Color fundus photograph. 2184 x 1690 pixels. 45° field of view.
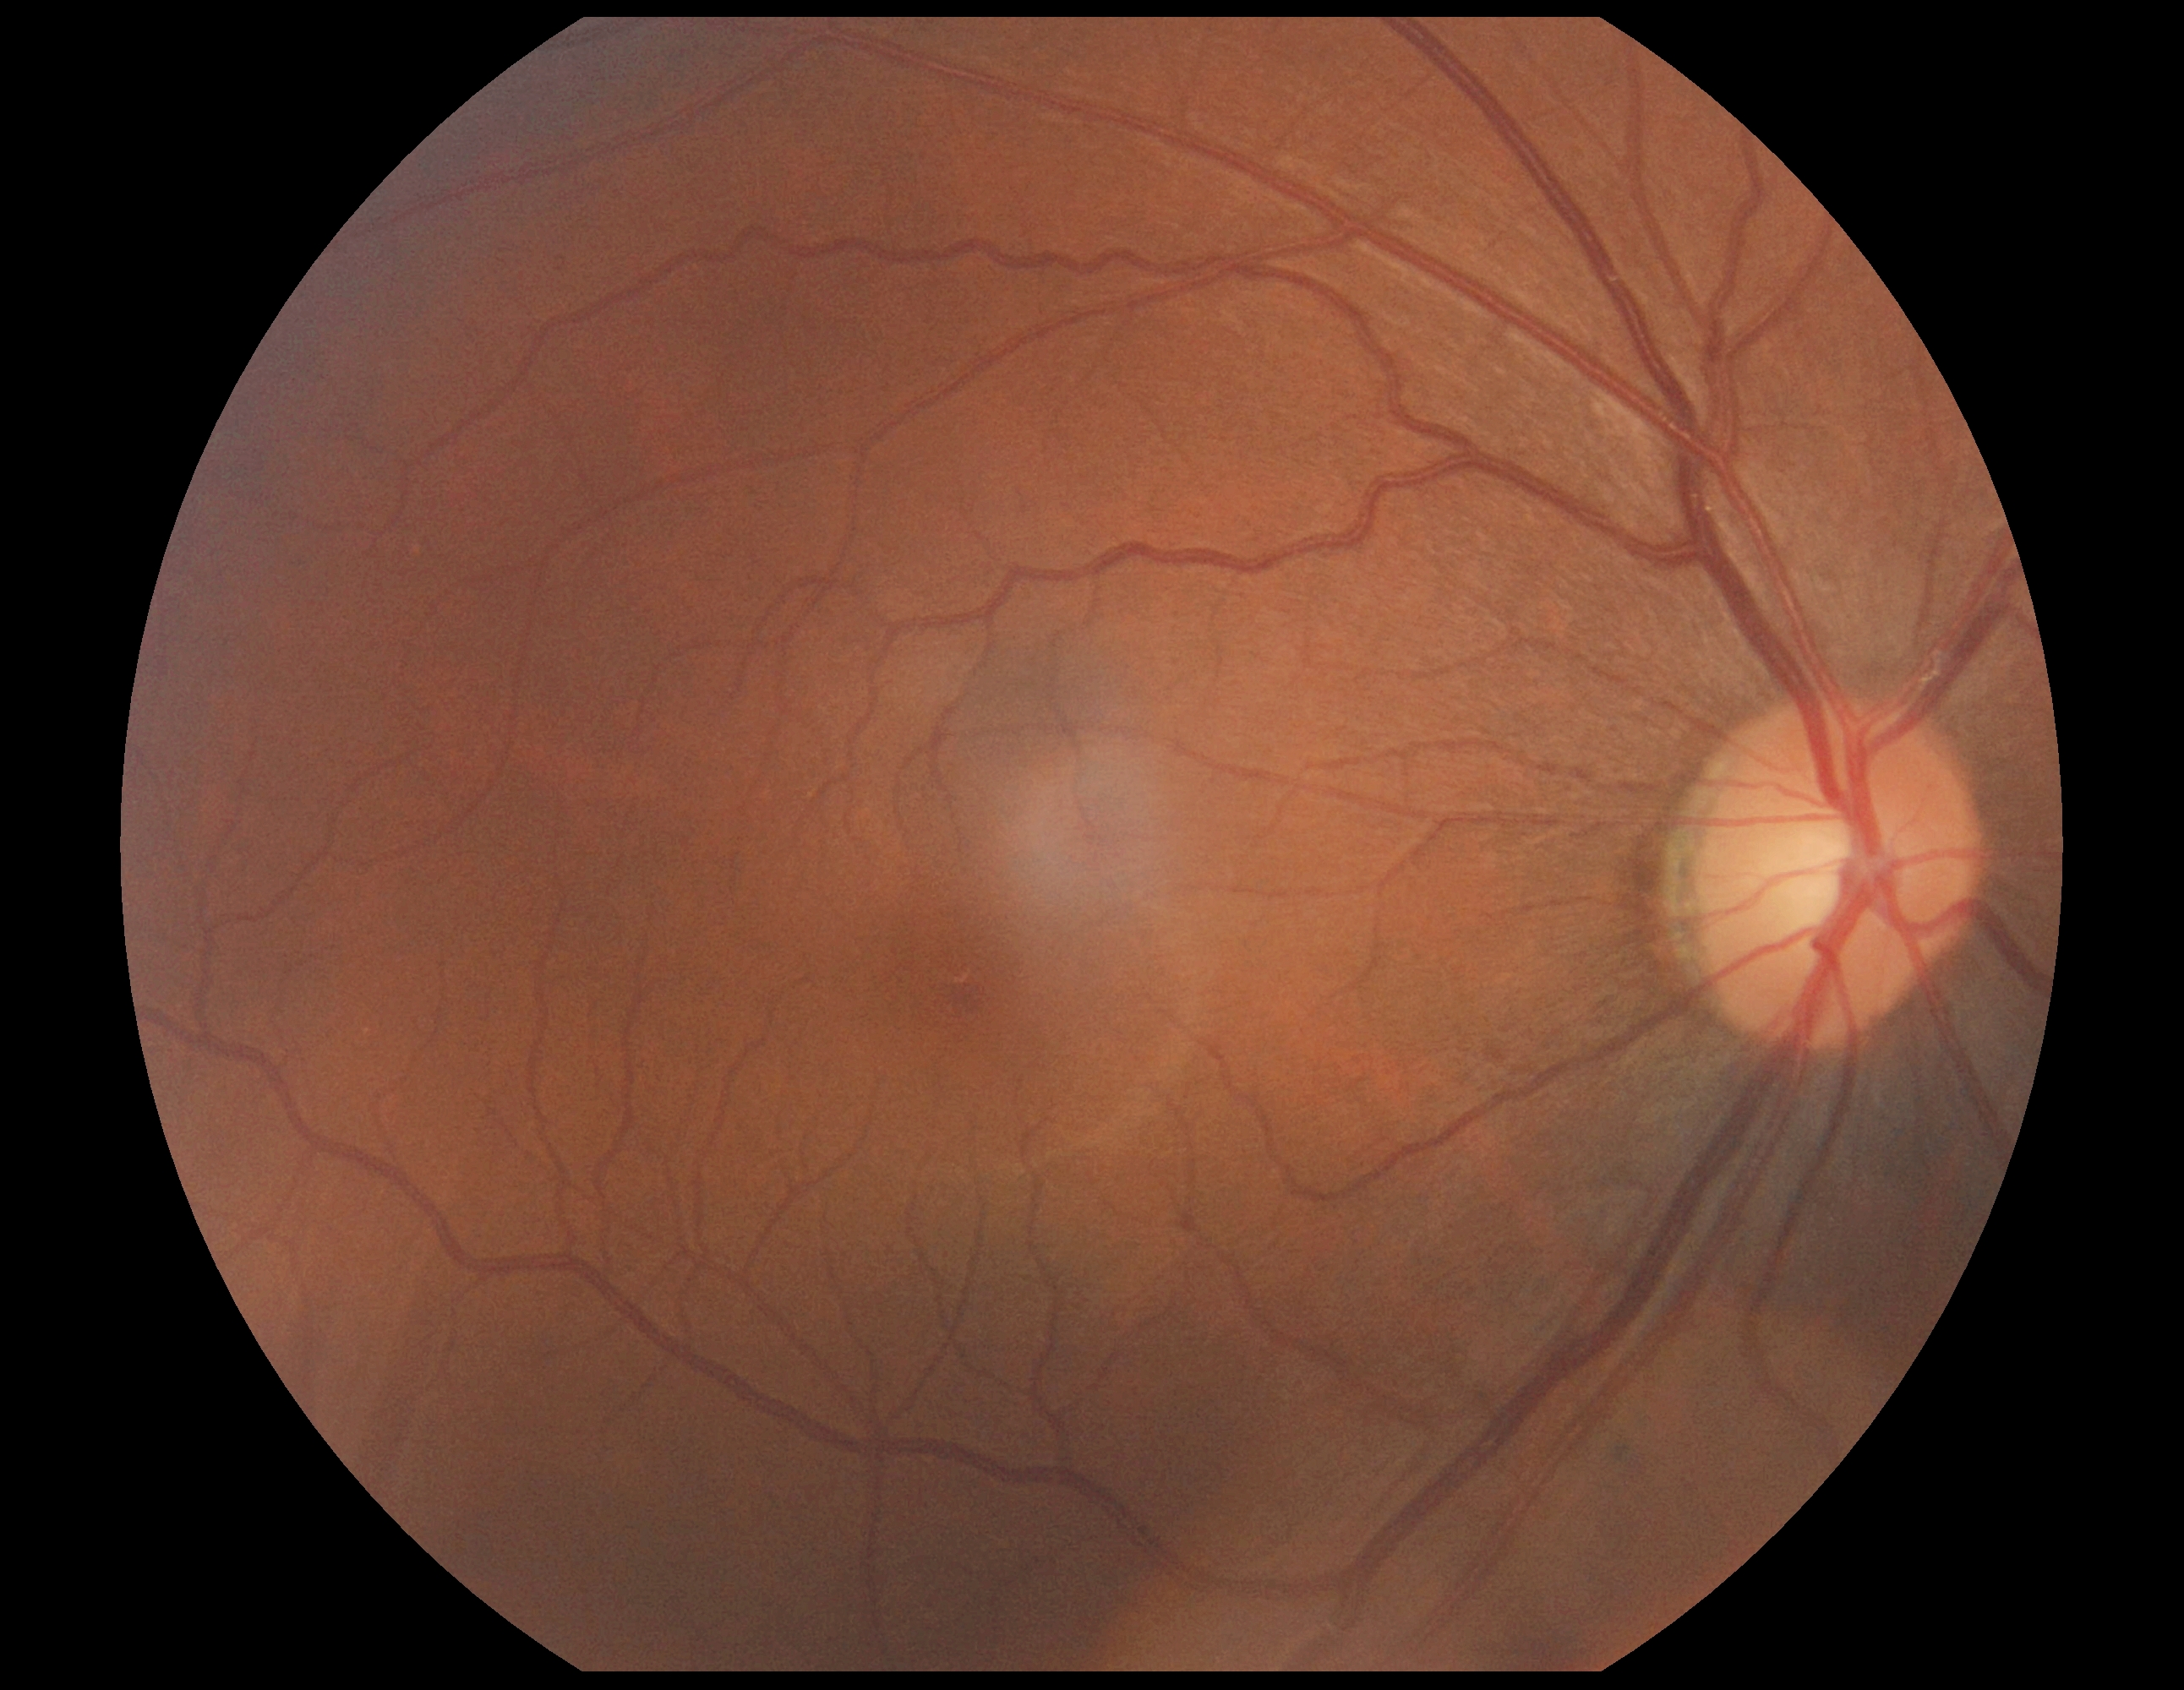 DR severity is grade 0 — no visible signs of diabetic retinopathy.